CFP · FOV: 45 degrees · 2352x1568.
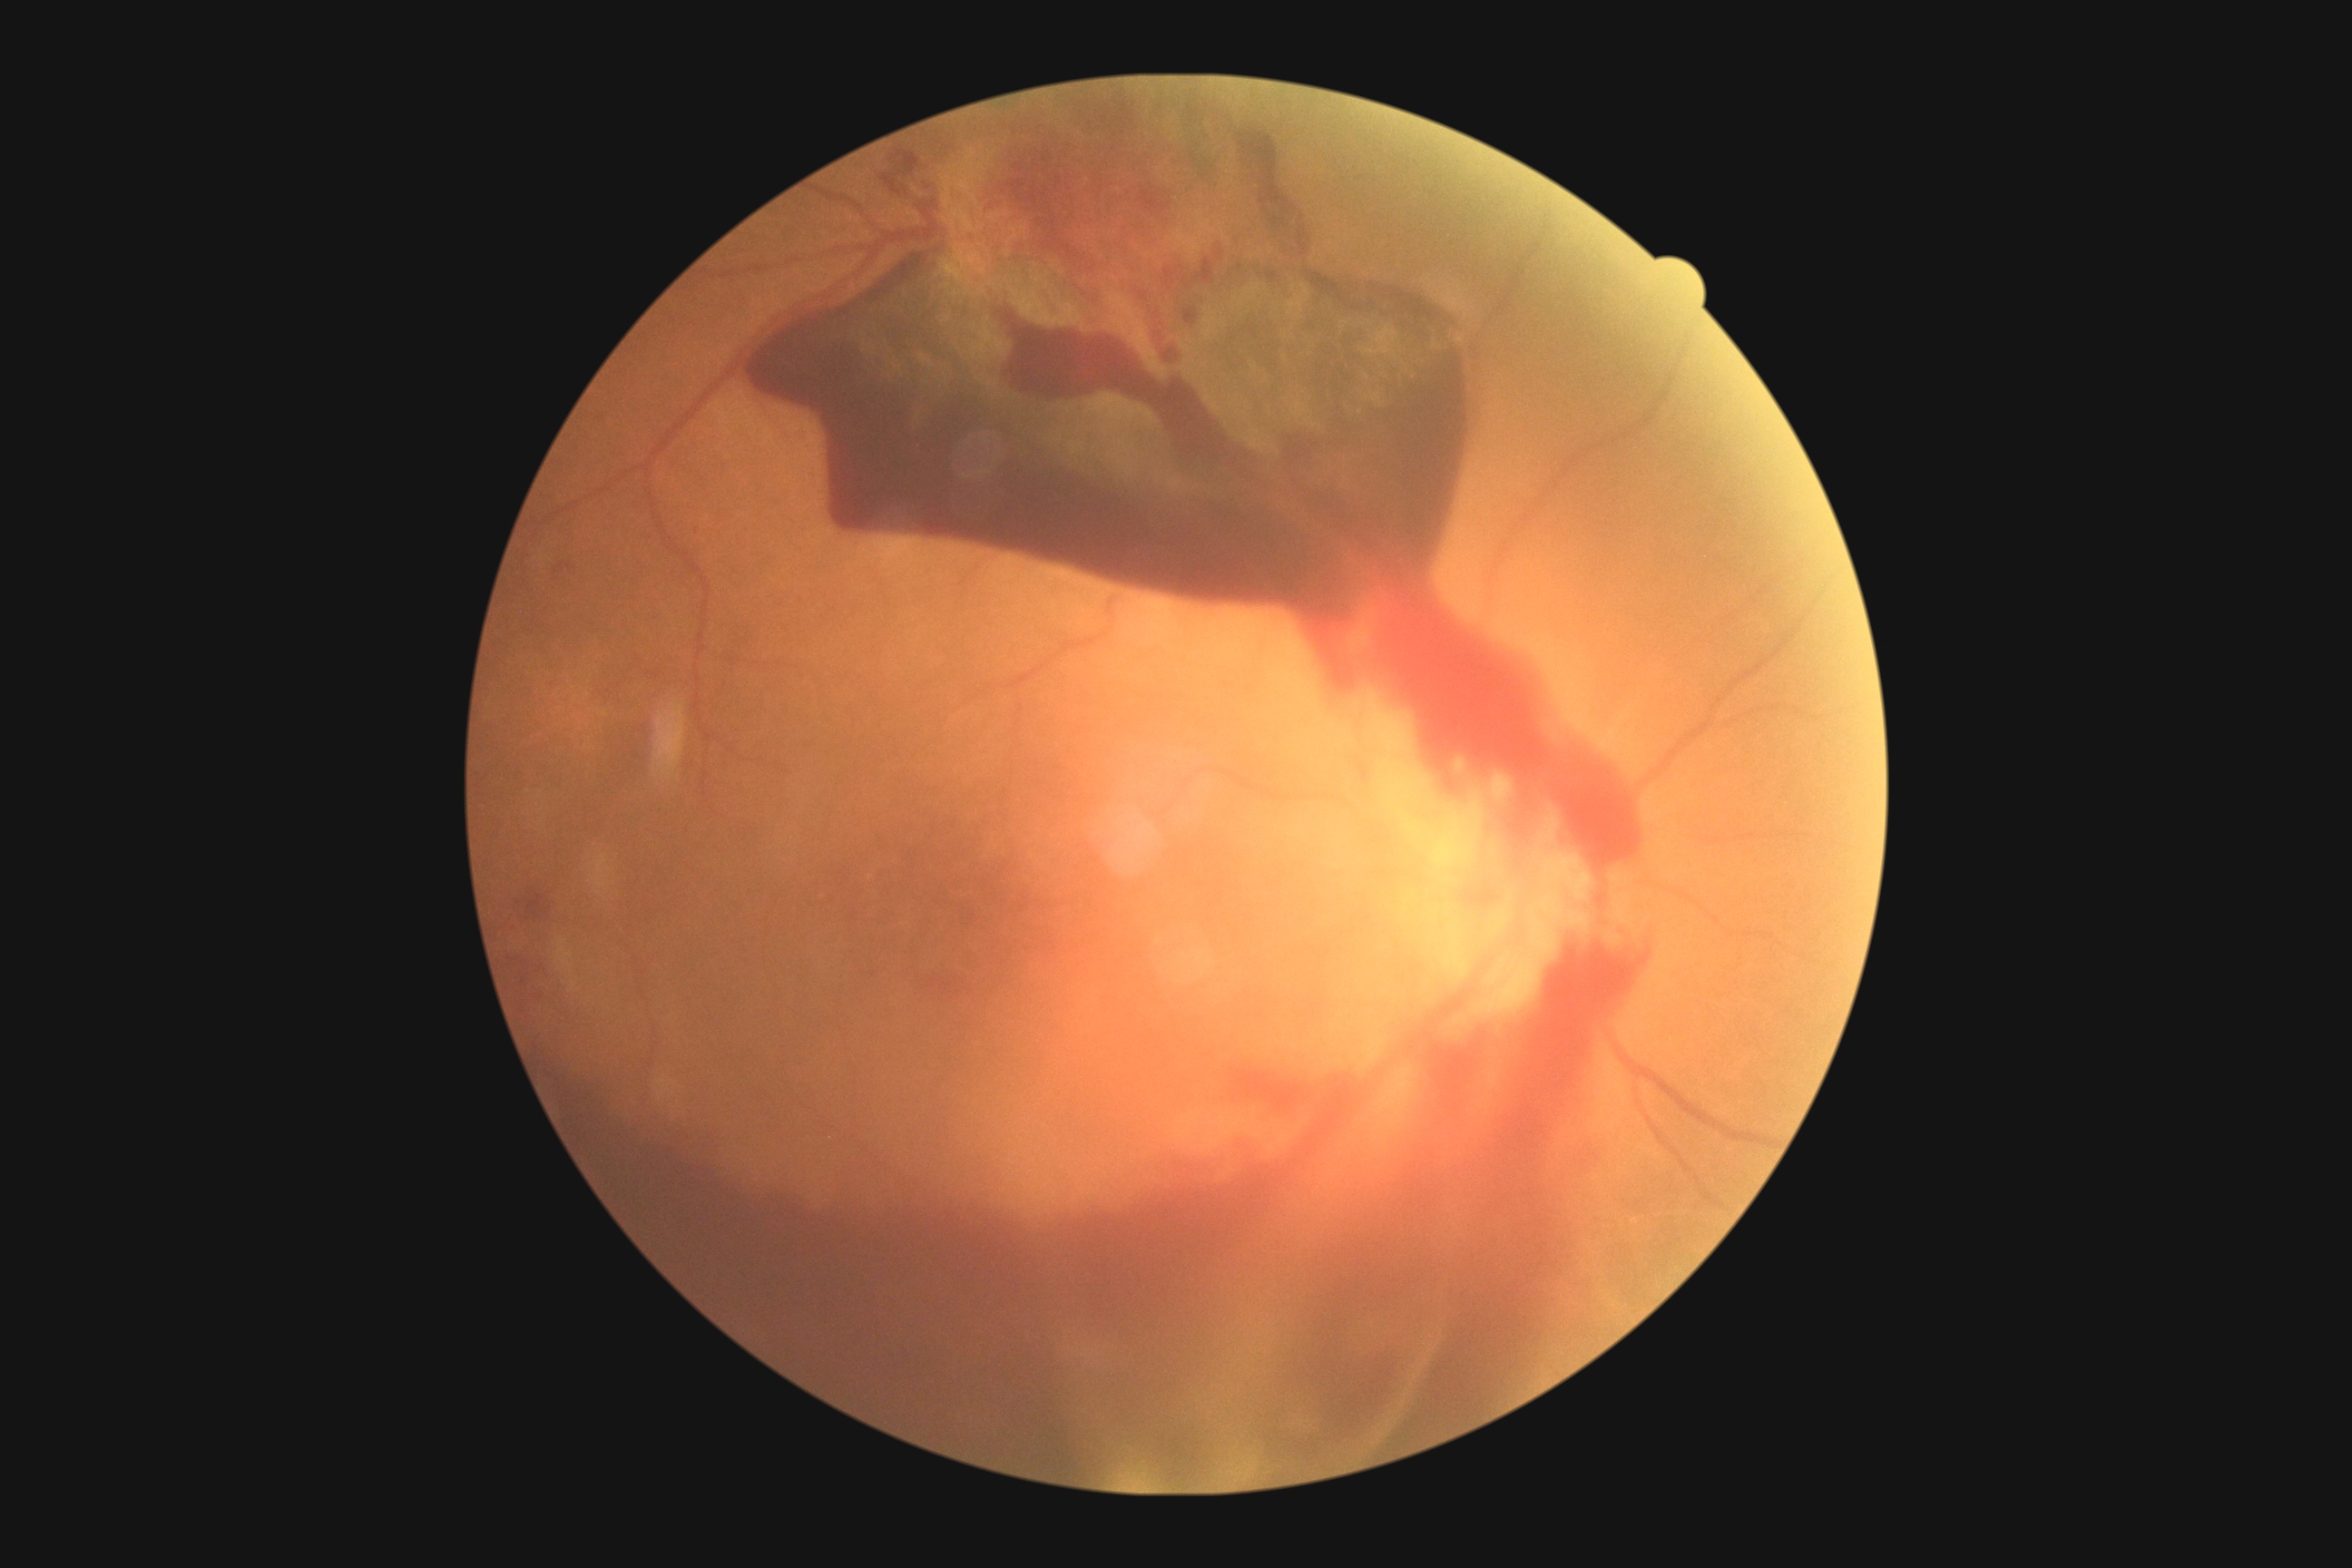 Diabetic retinopathy (DR): 4.